Retinal fundus photograph — 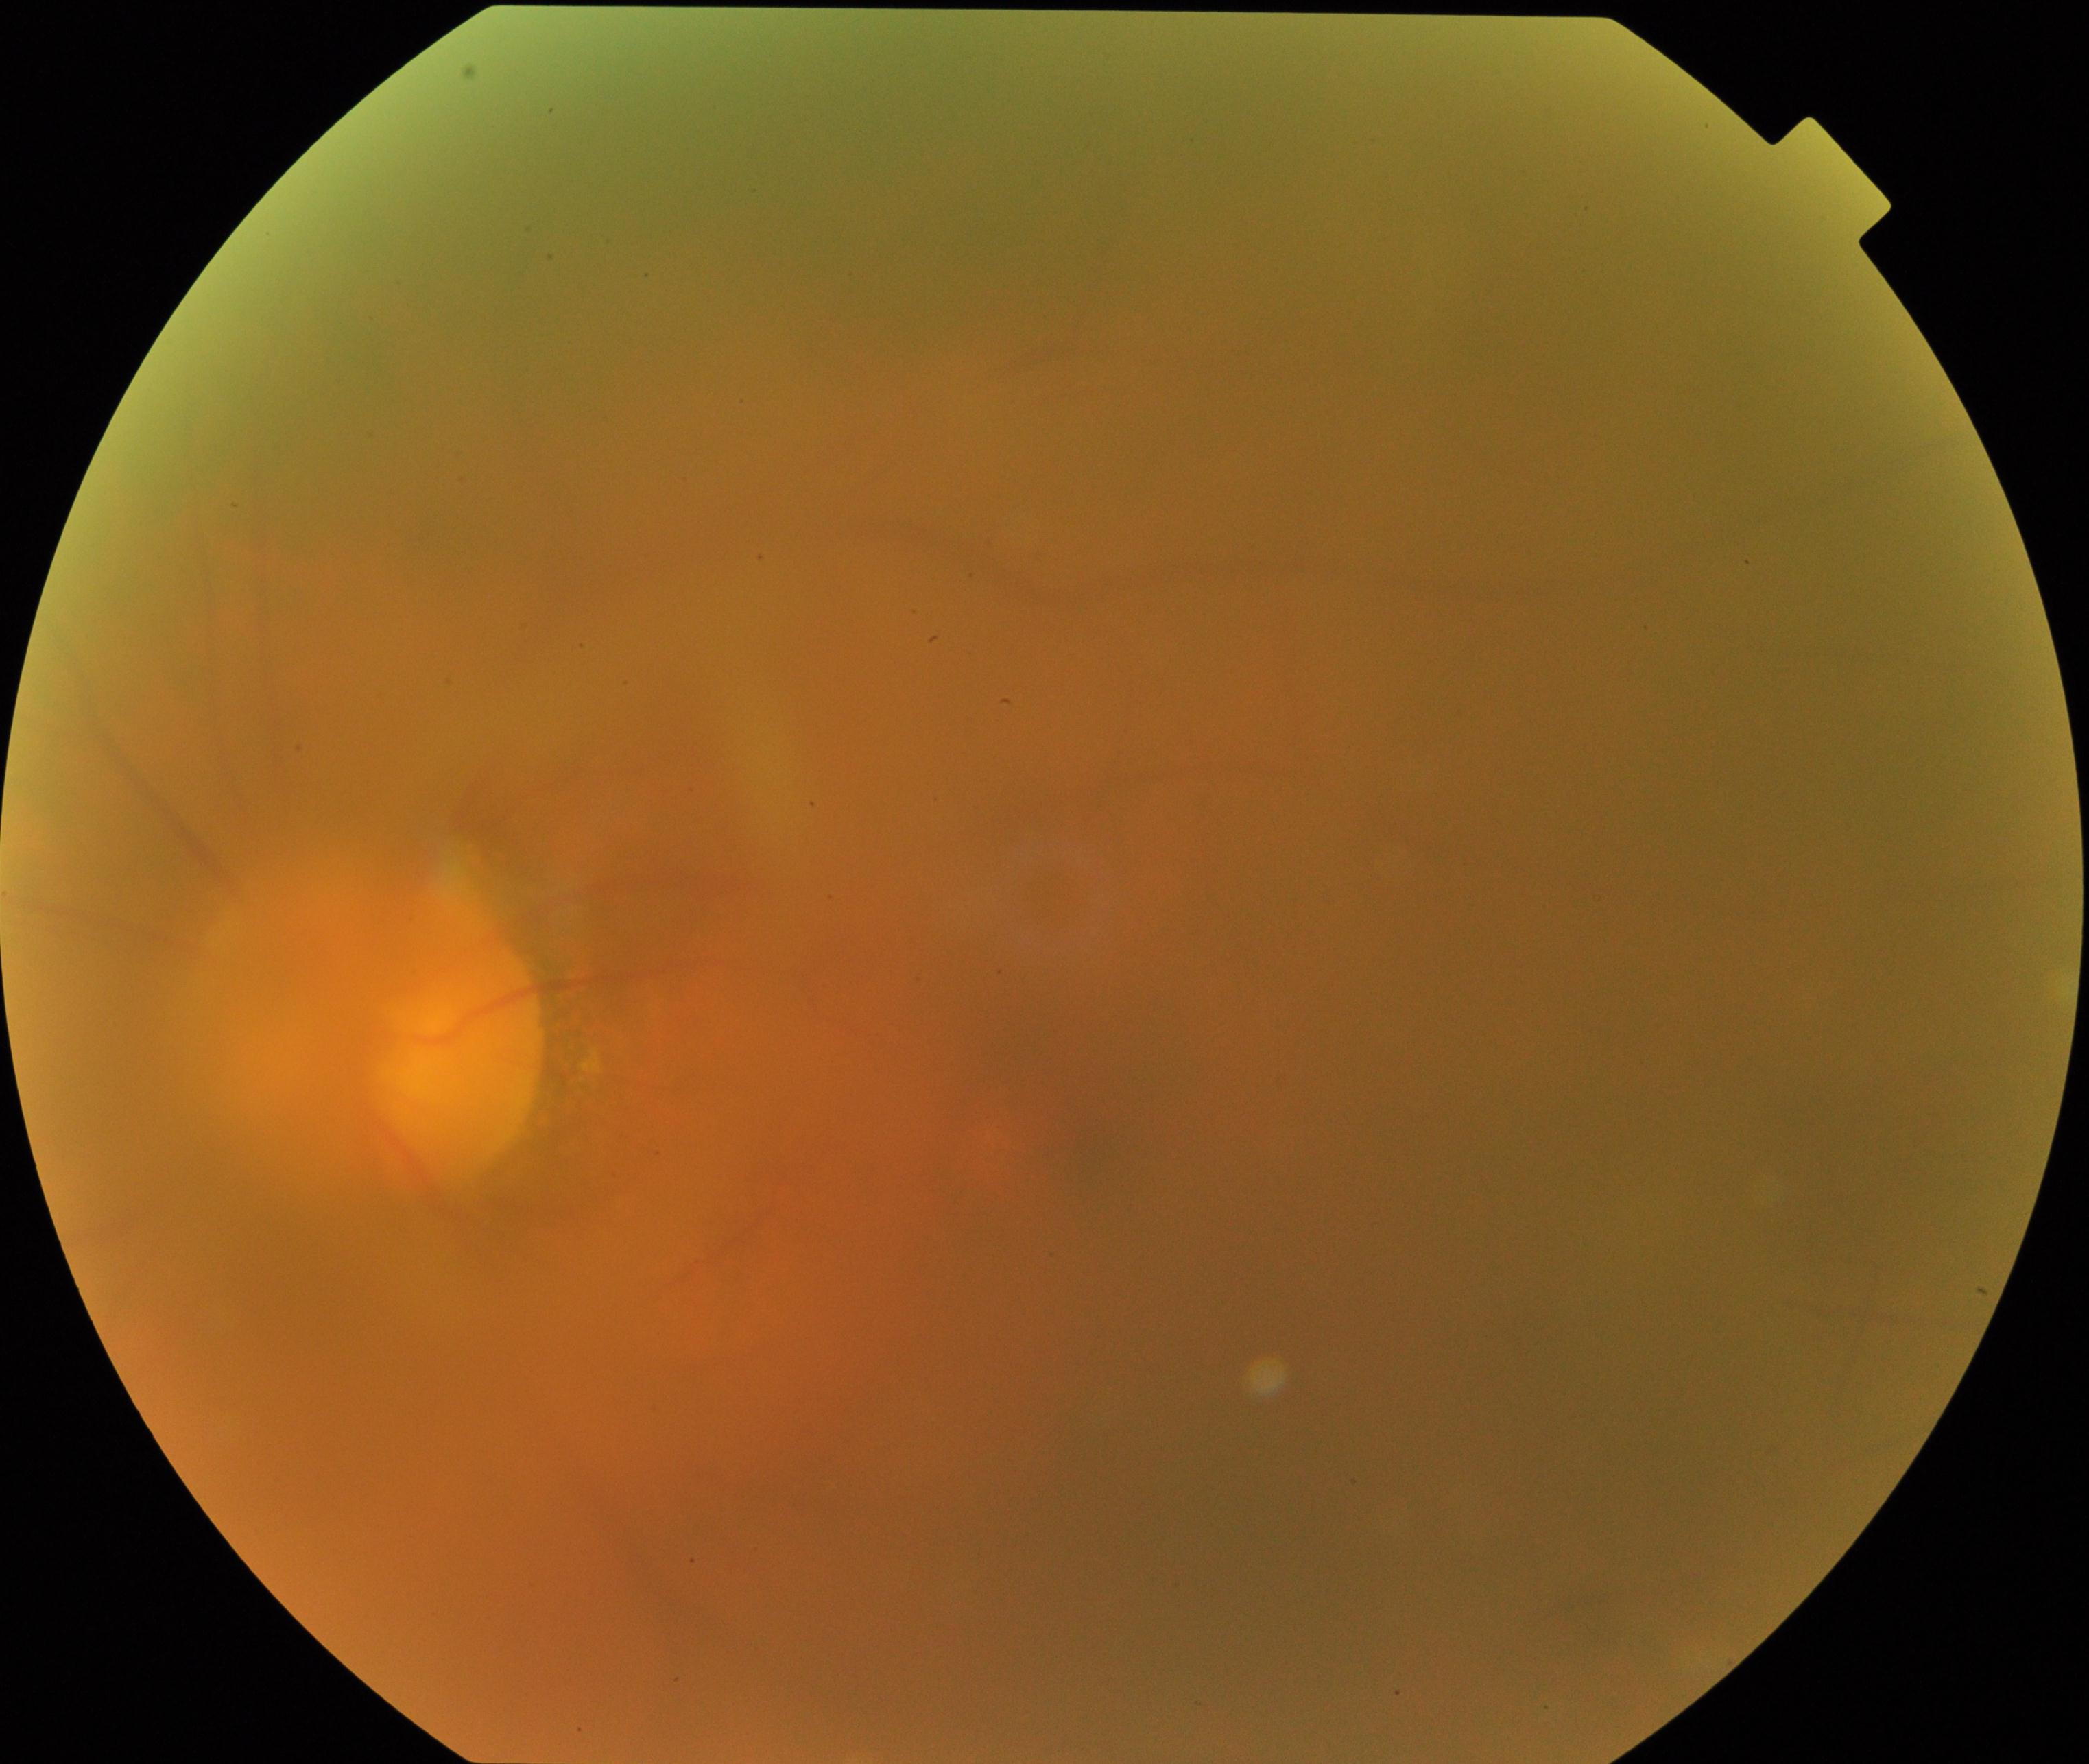

Image quality: blurred, more than half the field obscured.
Proliferative diabetic retinopathy: absent.